Wide-field contact fundus photograph of an infant · Natus RetCam Envision, 130° FOV — 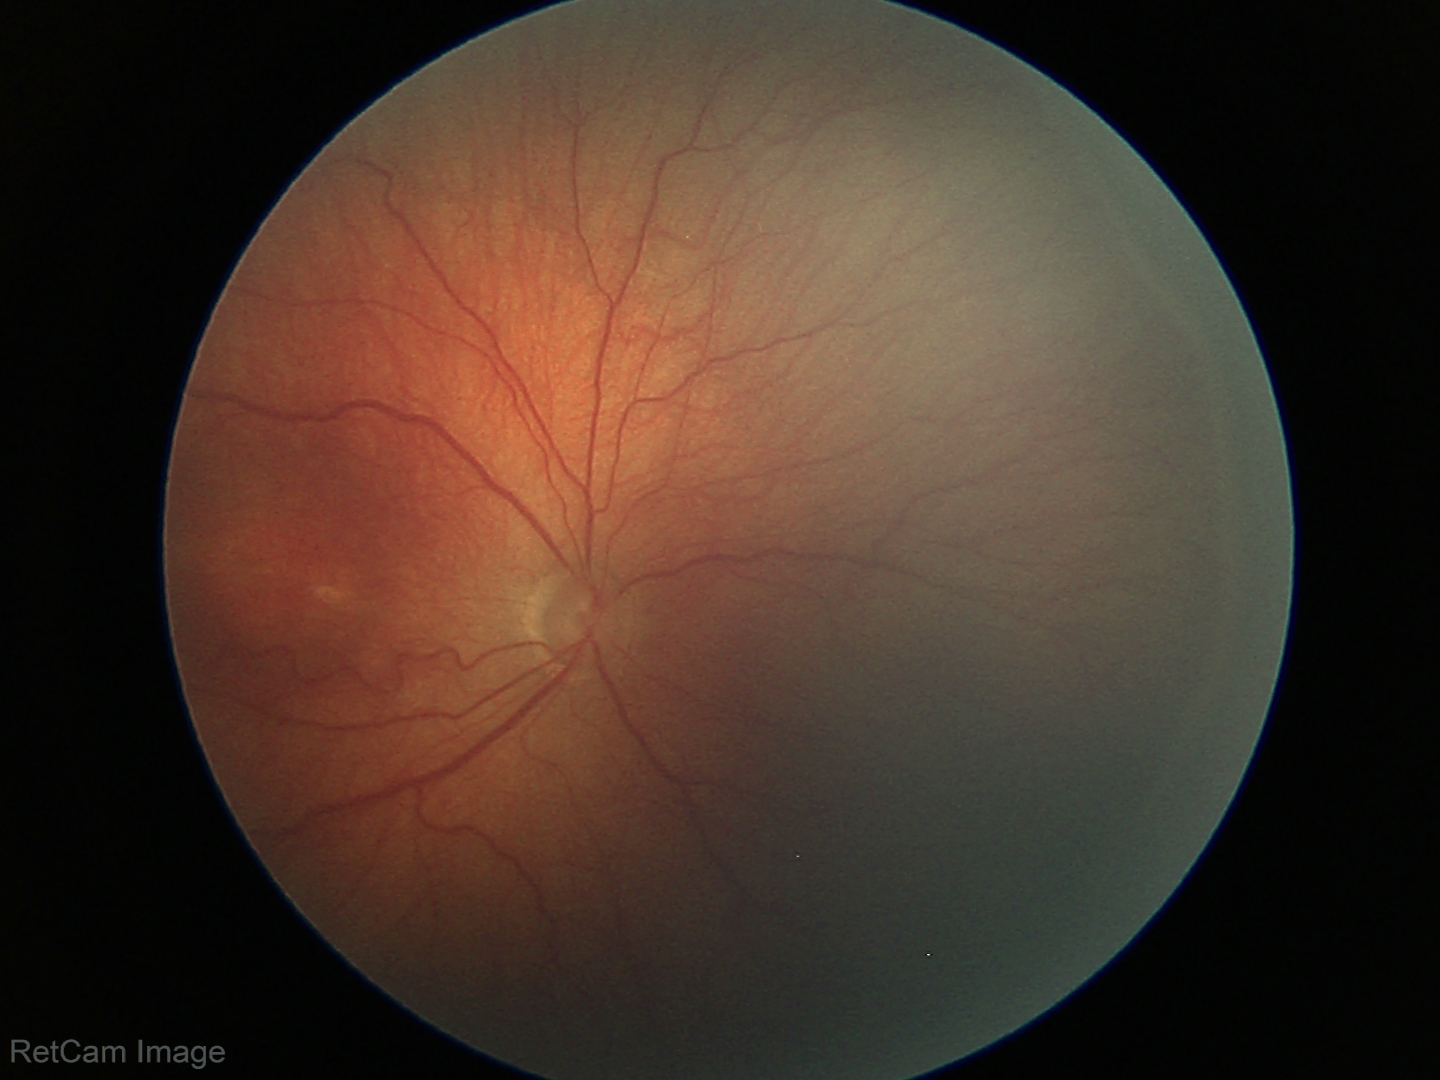
From an examination with diagnosis of ROP stage 3 — ridge with extraretinal fibrovascular proliferation.
Plus disease absent.